Modified Davis classification:
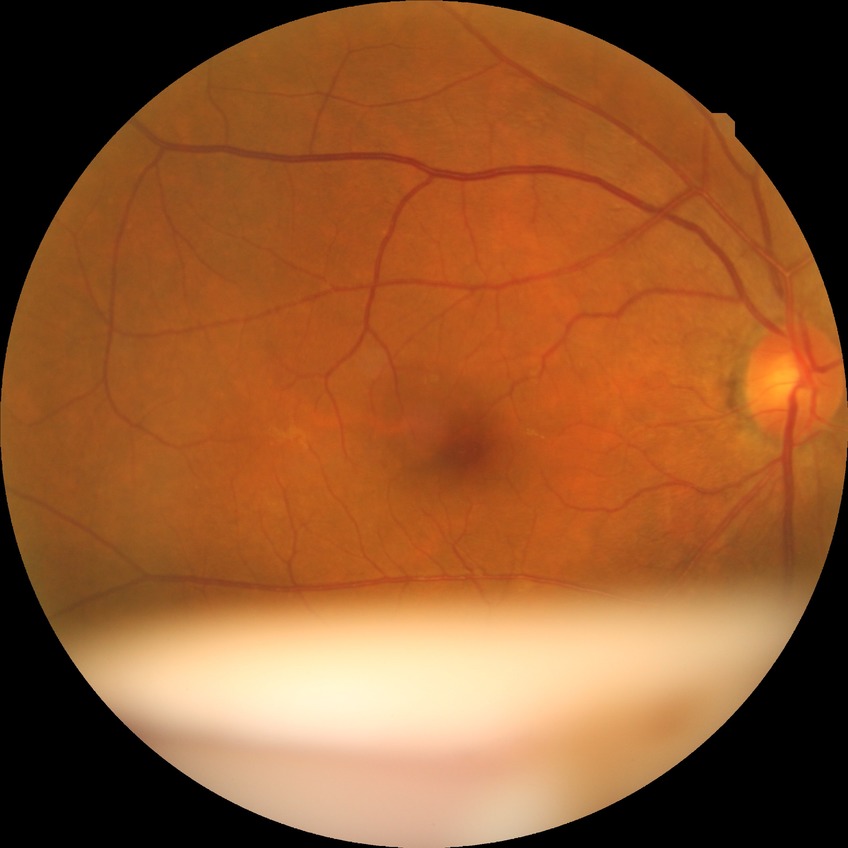 Diabetic retinopathy (DR) is NDR (no diabetic retinopathy).